Modified Davis classification. 45-degree field of view. No pharmacologic dilation:
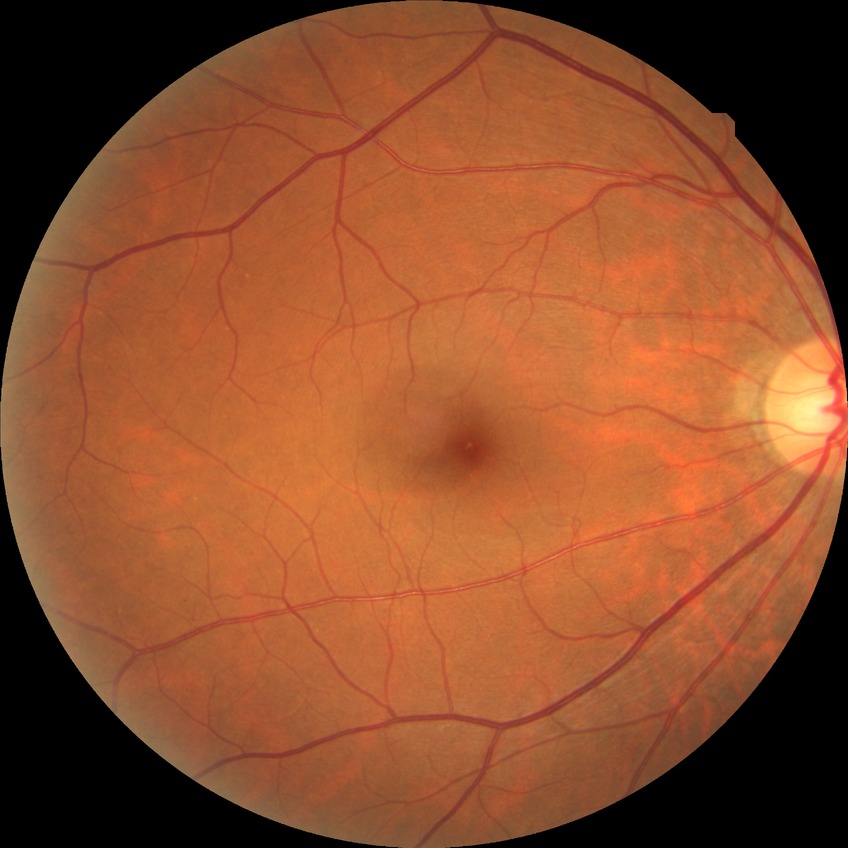
Diabetic retinopathy (DR) is no diabetic retinopathy (NDR).